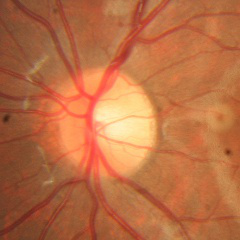 Demonstrates no glaucomatous findings.